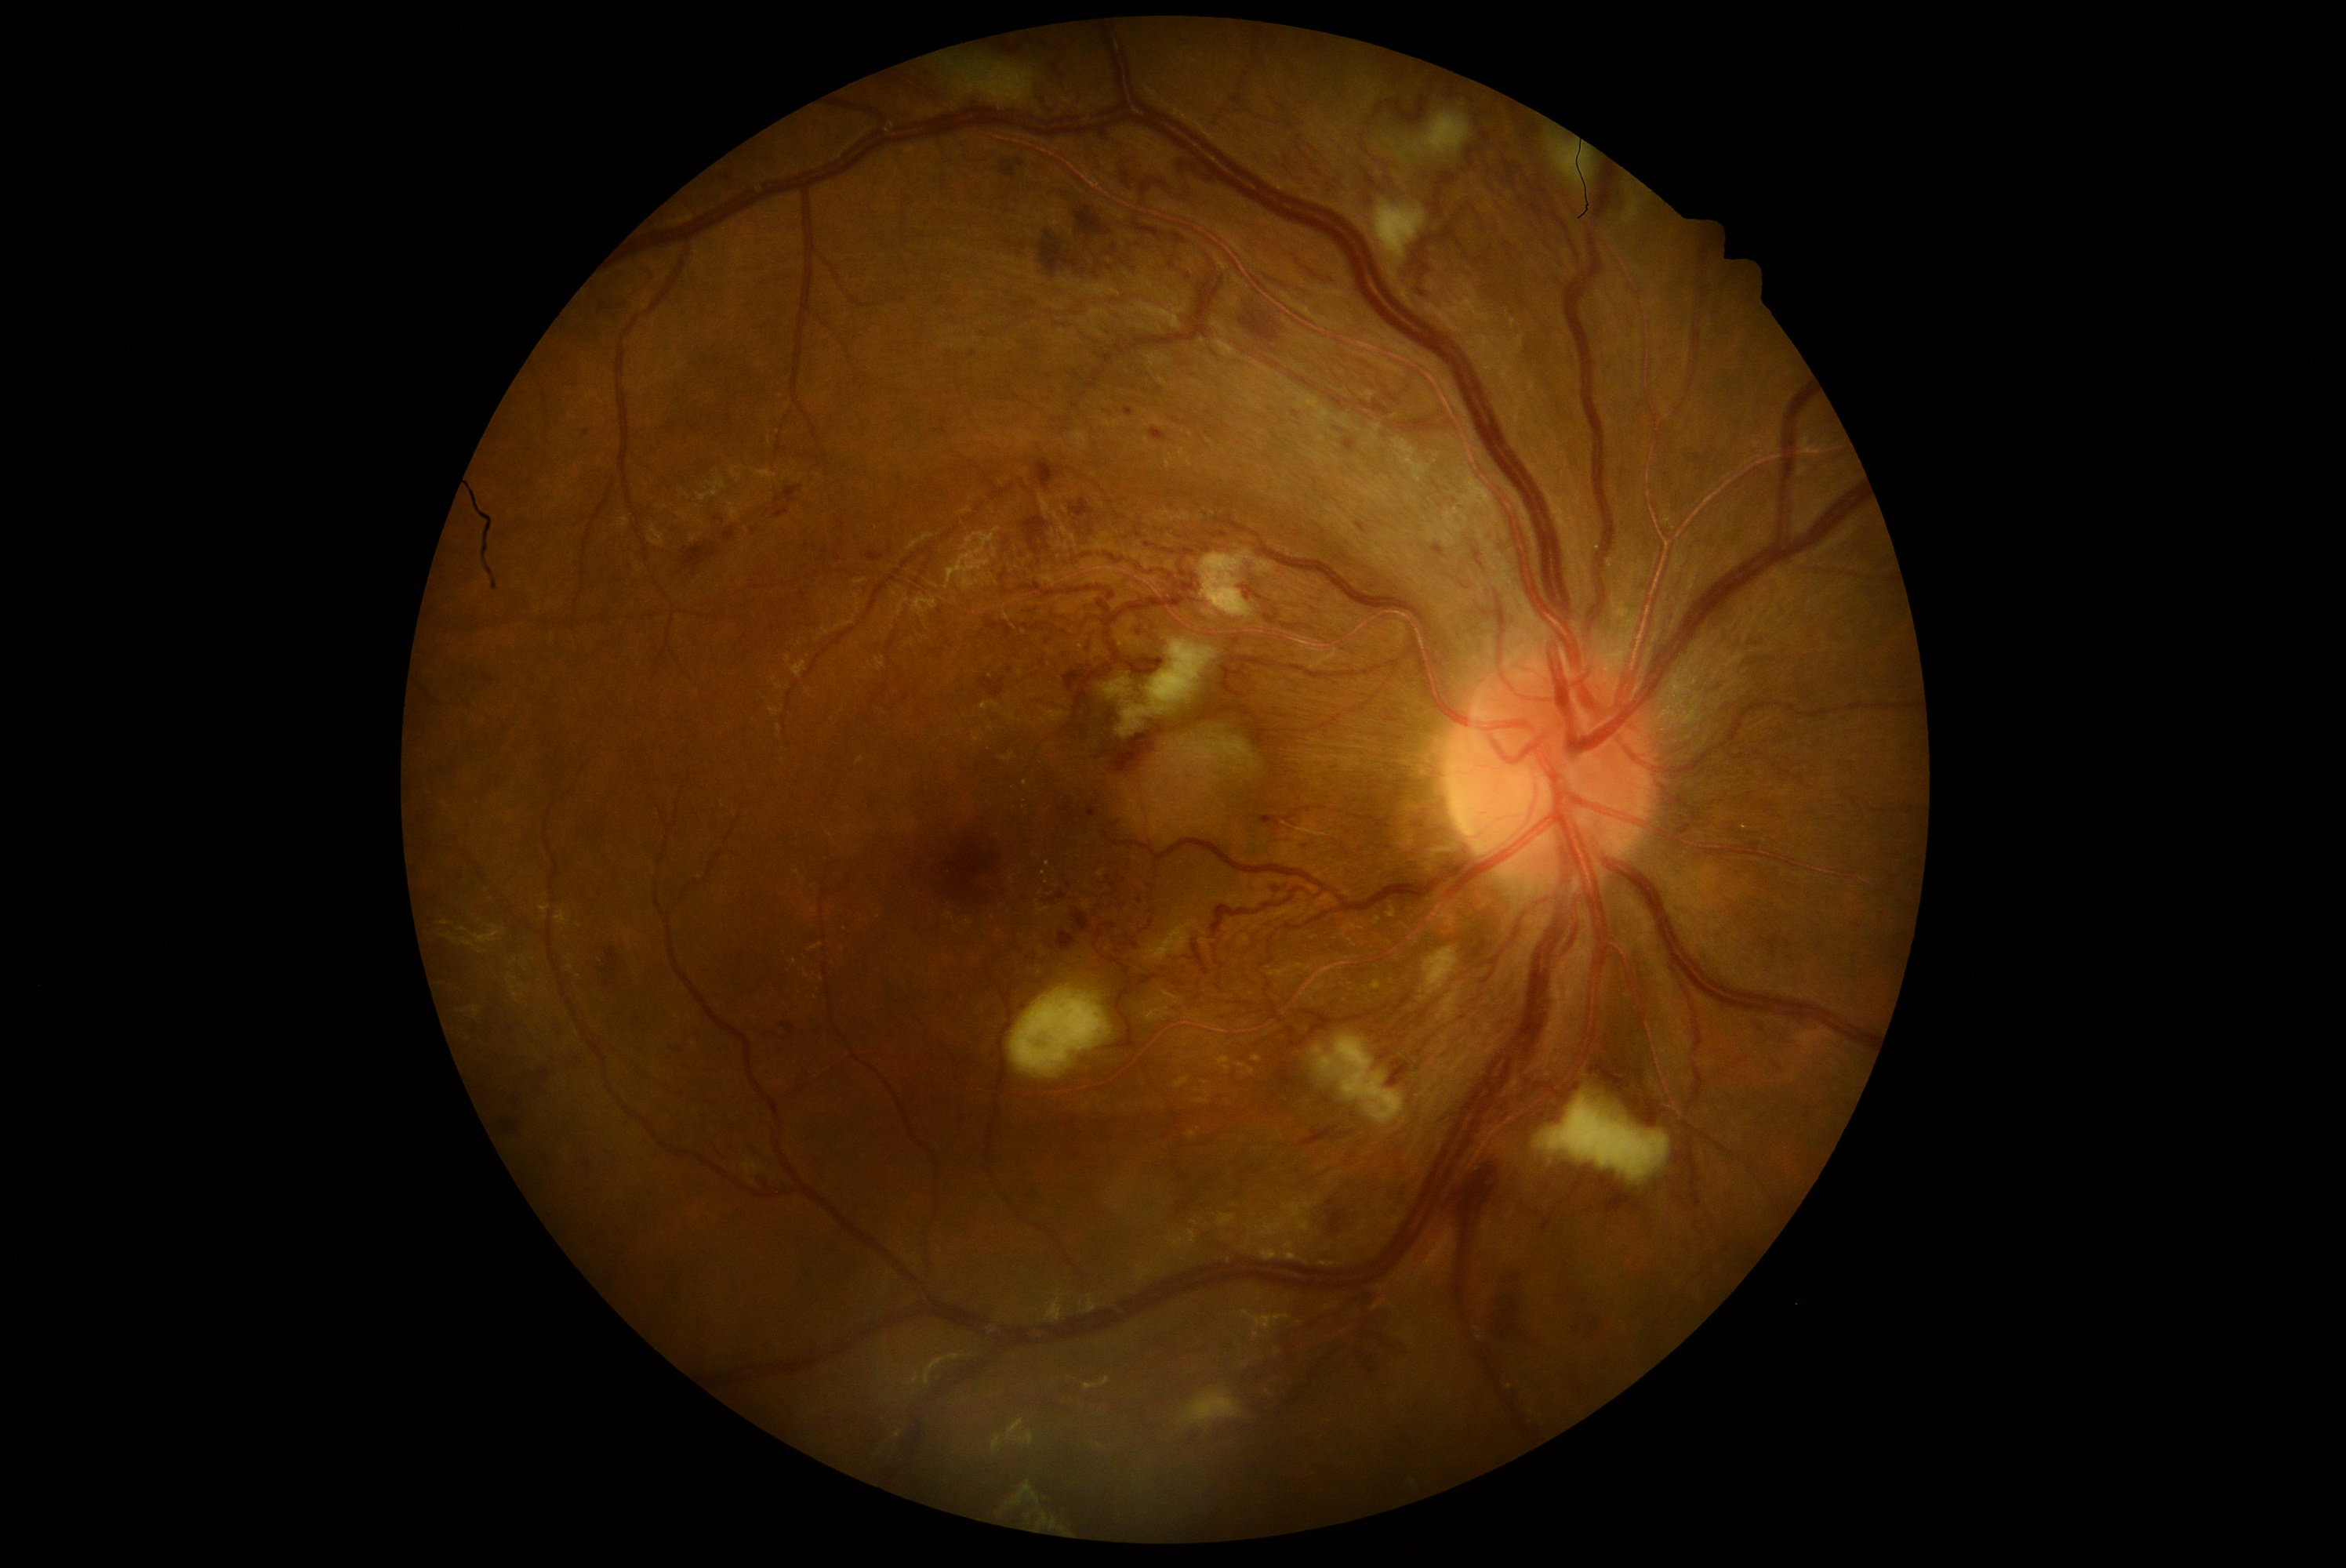
DR severity: 3
Selected lesions:
HEs (continued): bbox(1257, 811, 1268, 826), bbox(539, 1069, 548, 1081), bbox(1070, 242, 1092, 260), bbox(1015, 161, 1023, 165), bbox(1232, 637, 1241, 648), bbox(1073, 912, 1092, 934), bbox(510, 1092, 525, 1116), bbox(1039, 231, 1078, 277), bbox(1491, 1266, 1549, 1356), bbox(1034, 459, 1058, 490), bbox(760, 1175, 775, 1192), bbox(750, 526, 760, 535), bbox(714, 517, 725, 523), bbox(1603, 1191, 1640, 1219), bbox(780, 1022, 794, 1039), bbox(1389, 1061, 1411, 1087), bbox(772, 484, 804, 520)
Small HEs approximately at x=1689 y=459